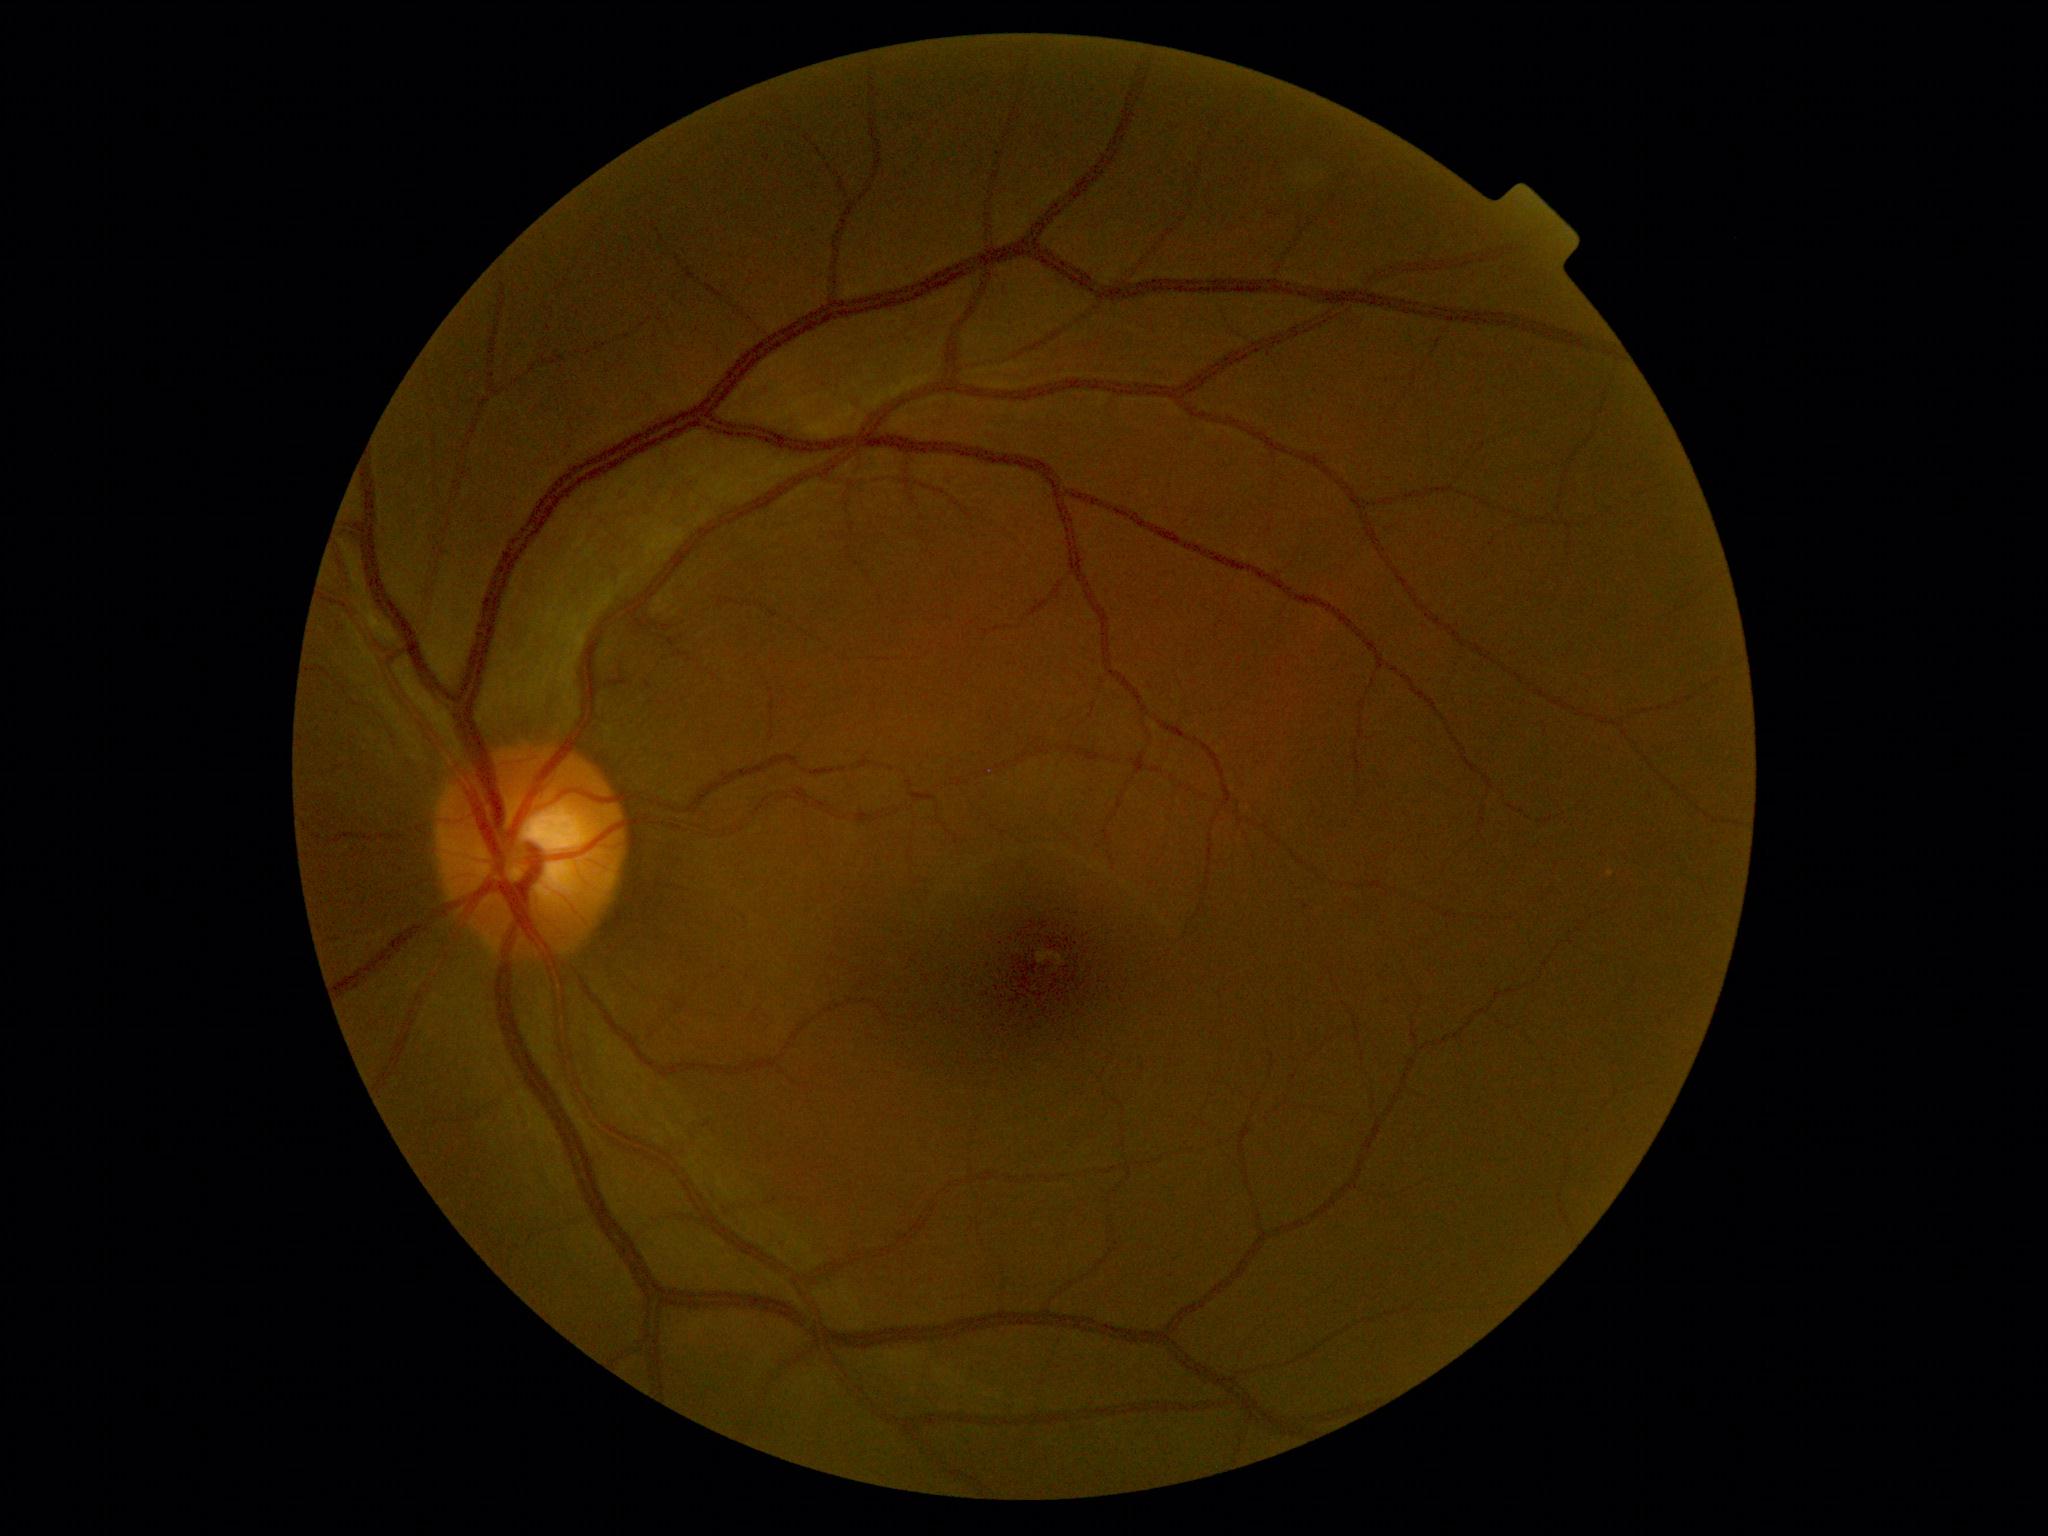 DR: 0. No apparent diabetic retinopathy.